Captured with the Phoenix ICON (100° field of view); infant wide-field fundus photograph:
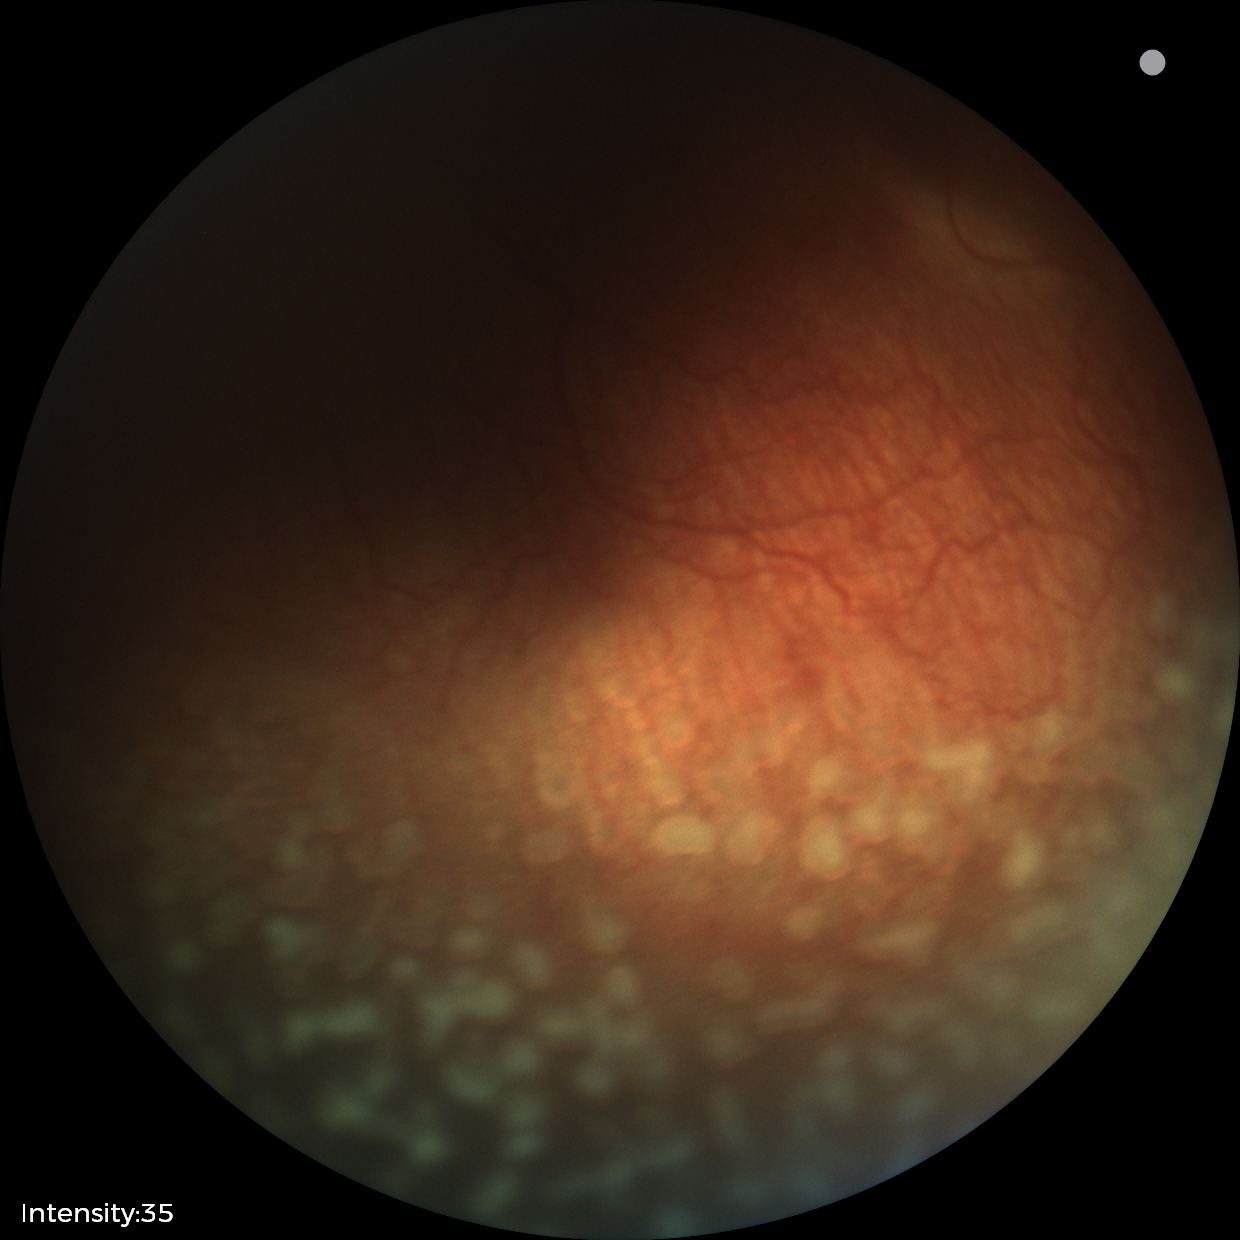

From an examination with diagnosis of ROP stage 2.